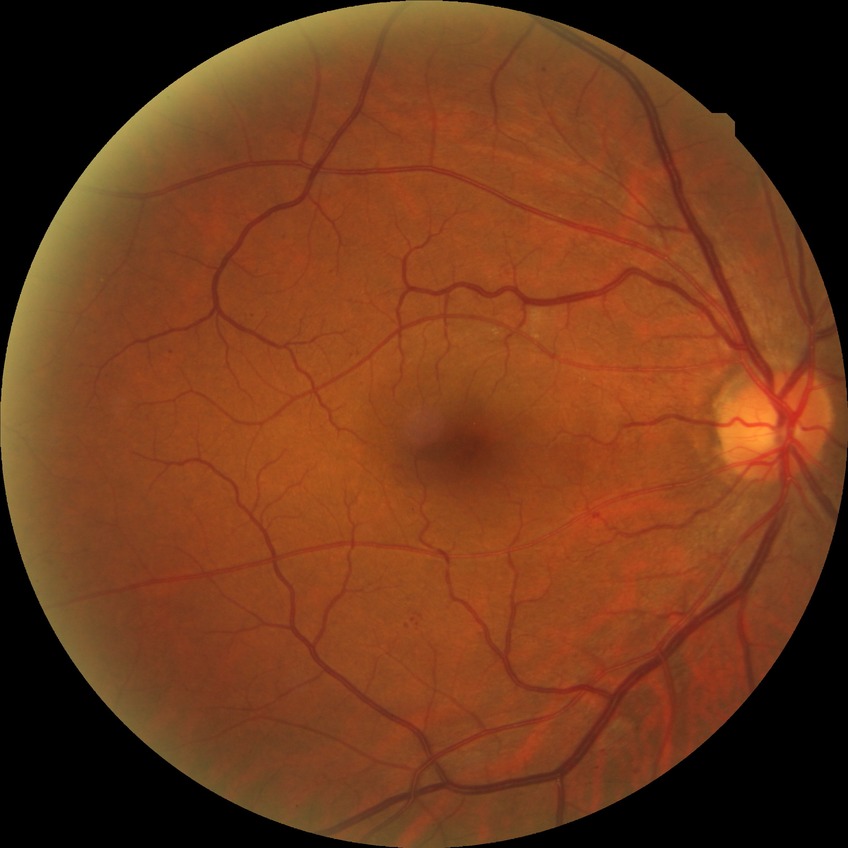 Diabetic retinopathy stage: simple diabetic retinopathy.